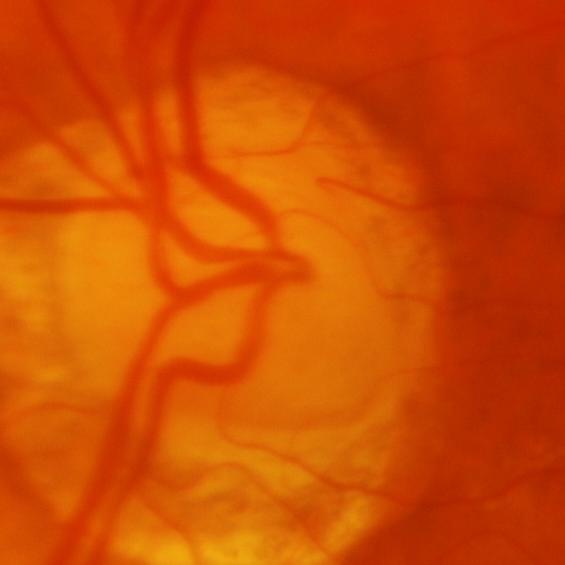

Q: Glaucoma assessment?
A: Glaucomatous findings.